Clarity RetCam 3, 130° FOV; wide-field fundus image from infant ROP screening.
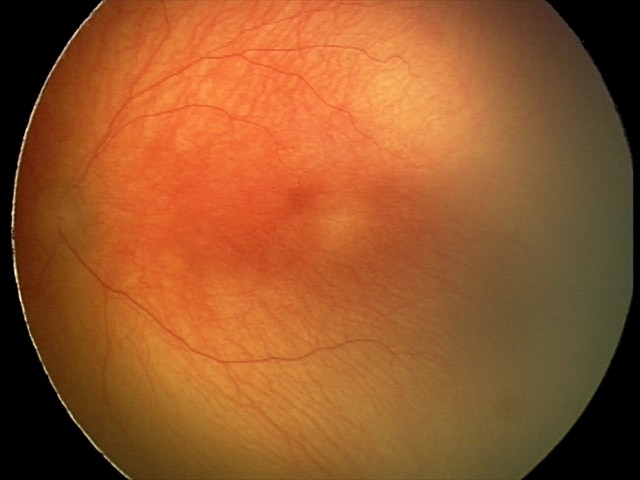
Plus disease present.
From an examination with diagnosis of A-ROP (aggressive ROP).